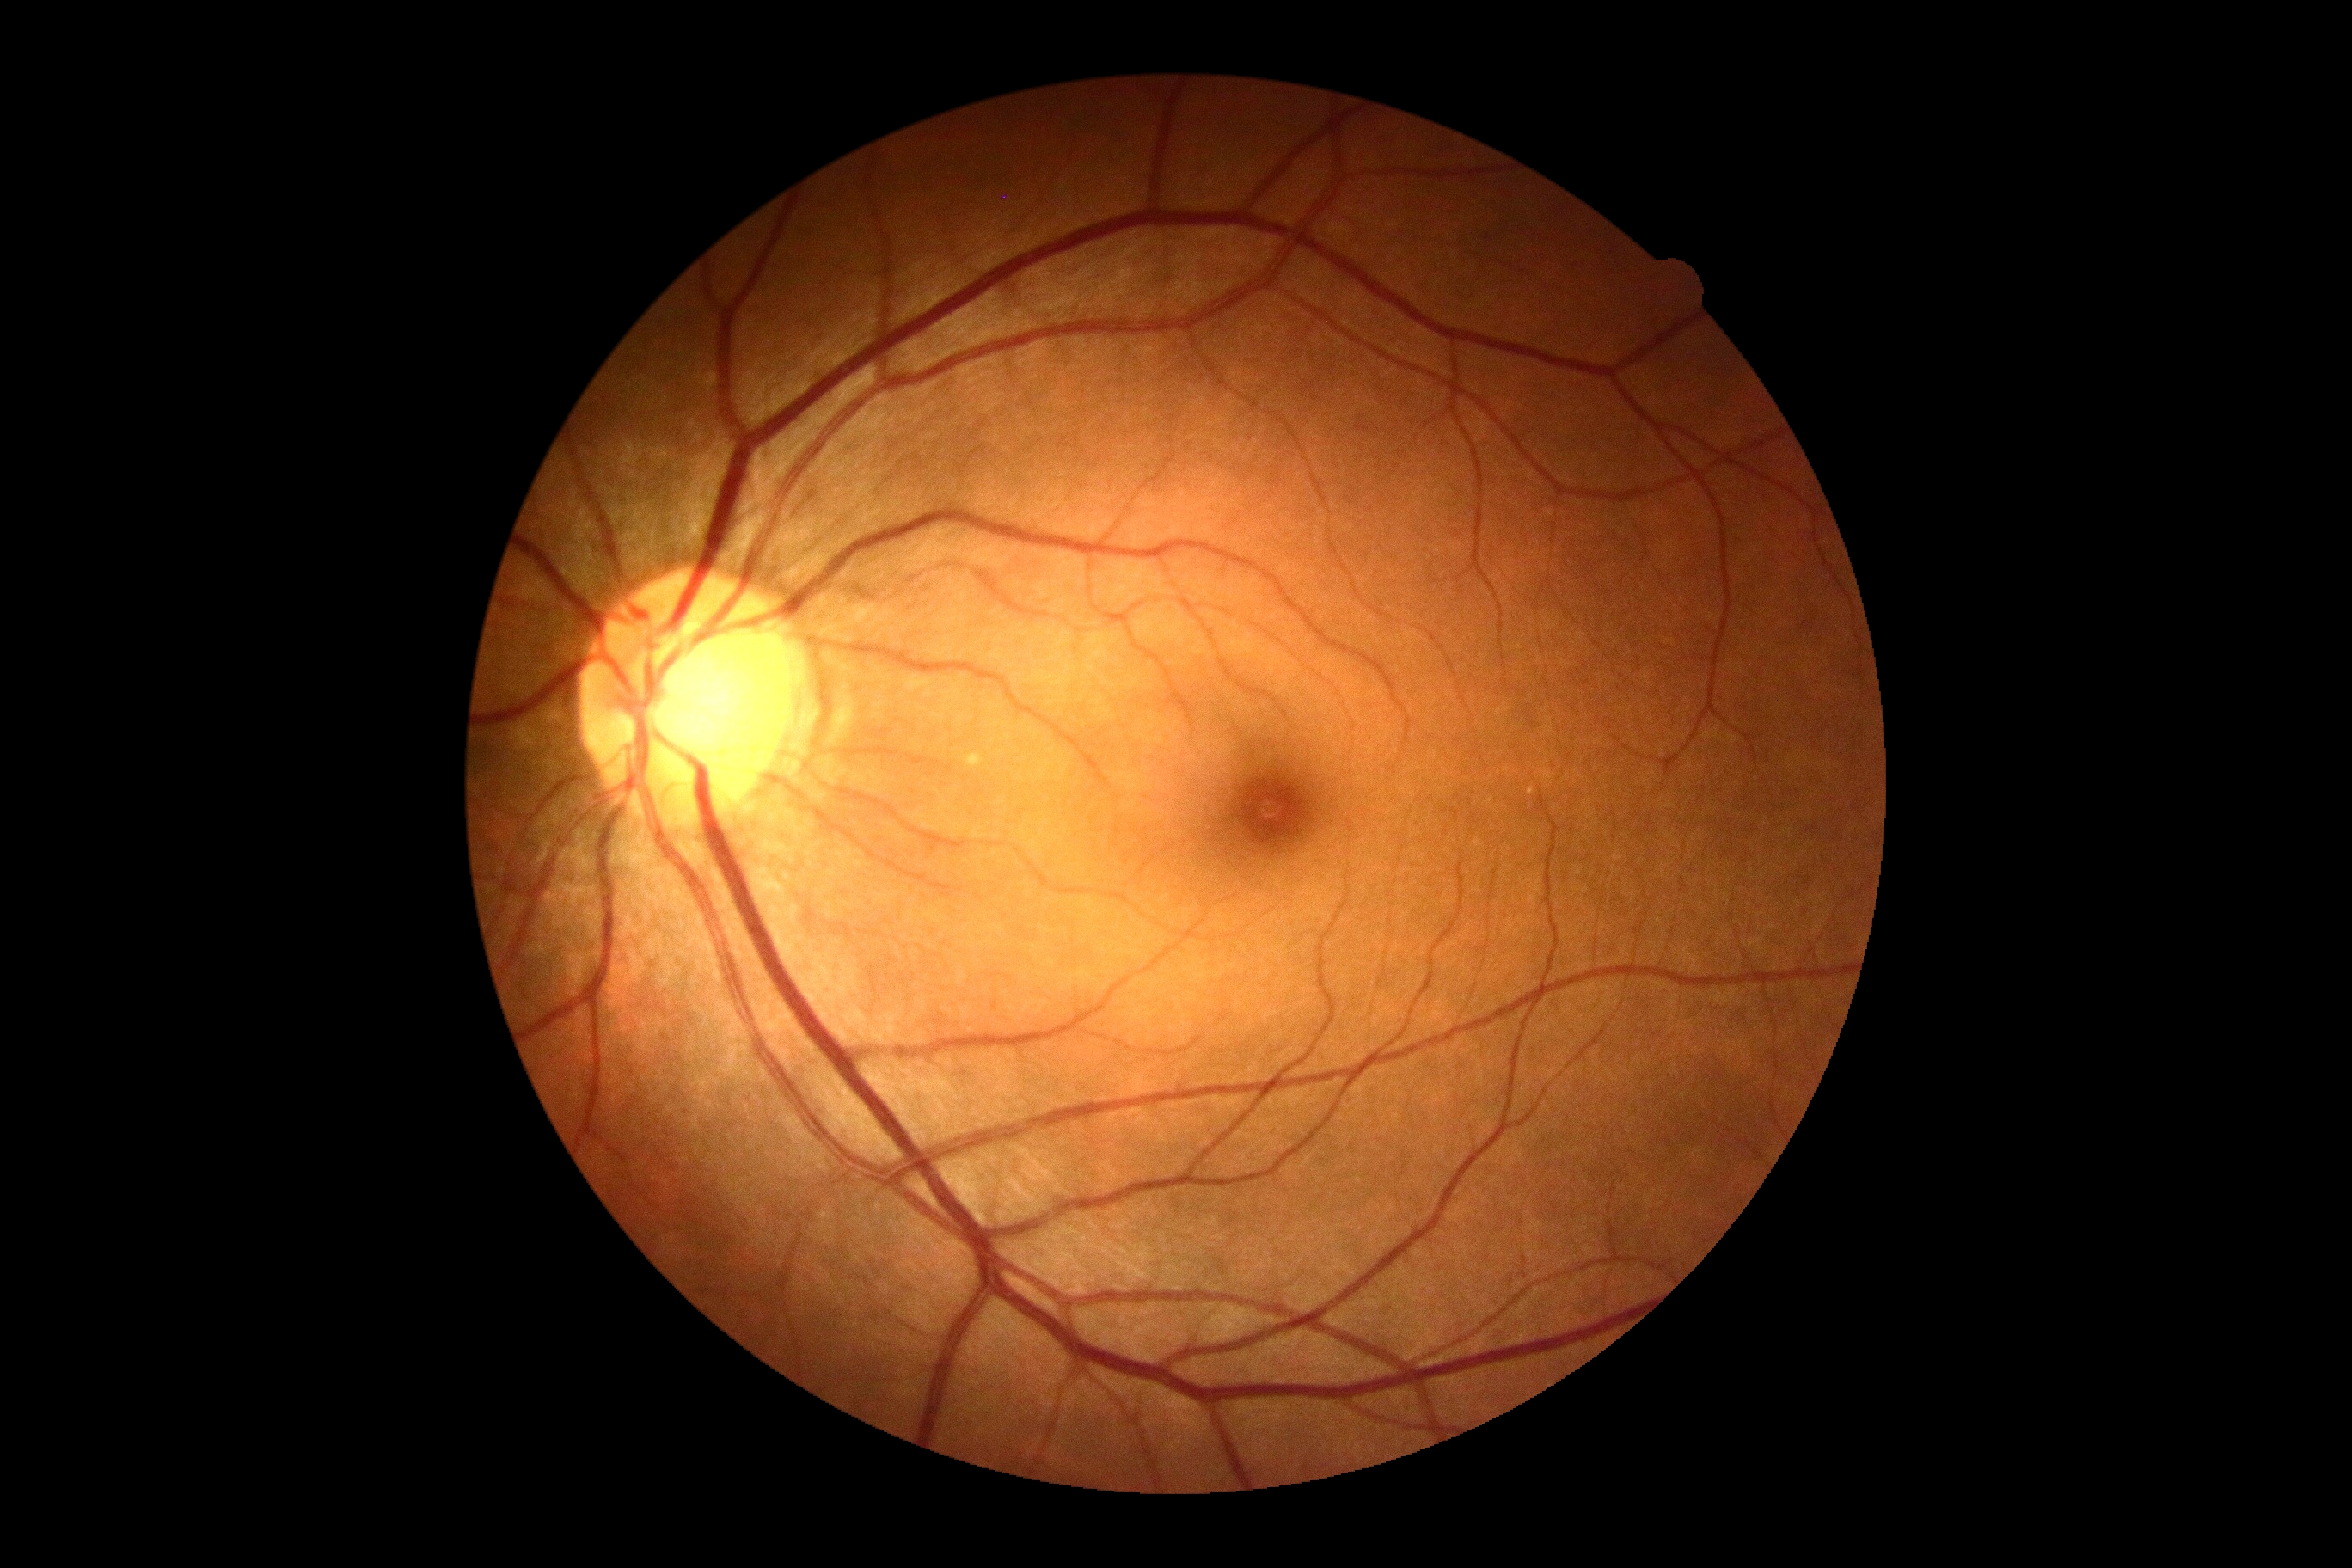

Diabetic retinopathy grade is 0 — no visible signs of diabetic retinopathy.